240x240 — 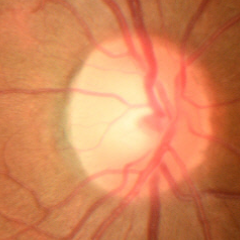
Glaucoma diagnosis: no glaucomatous optic neuropathy.